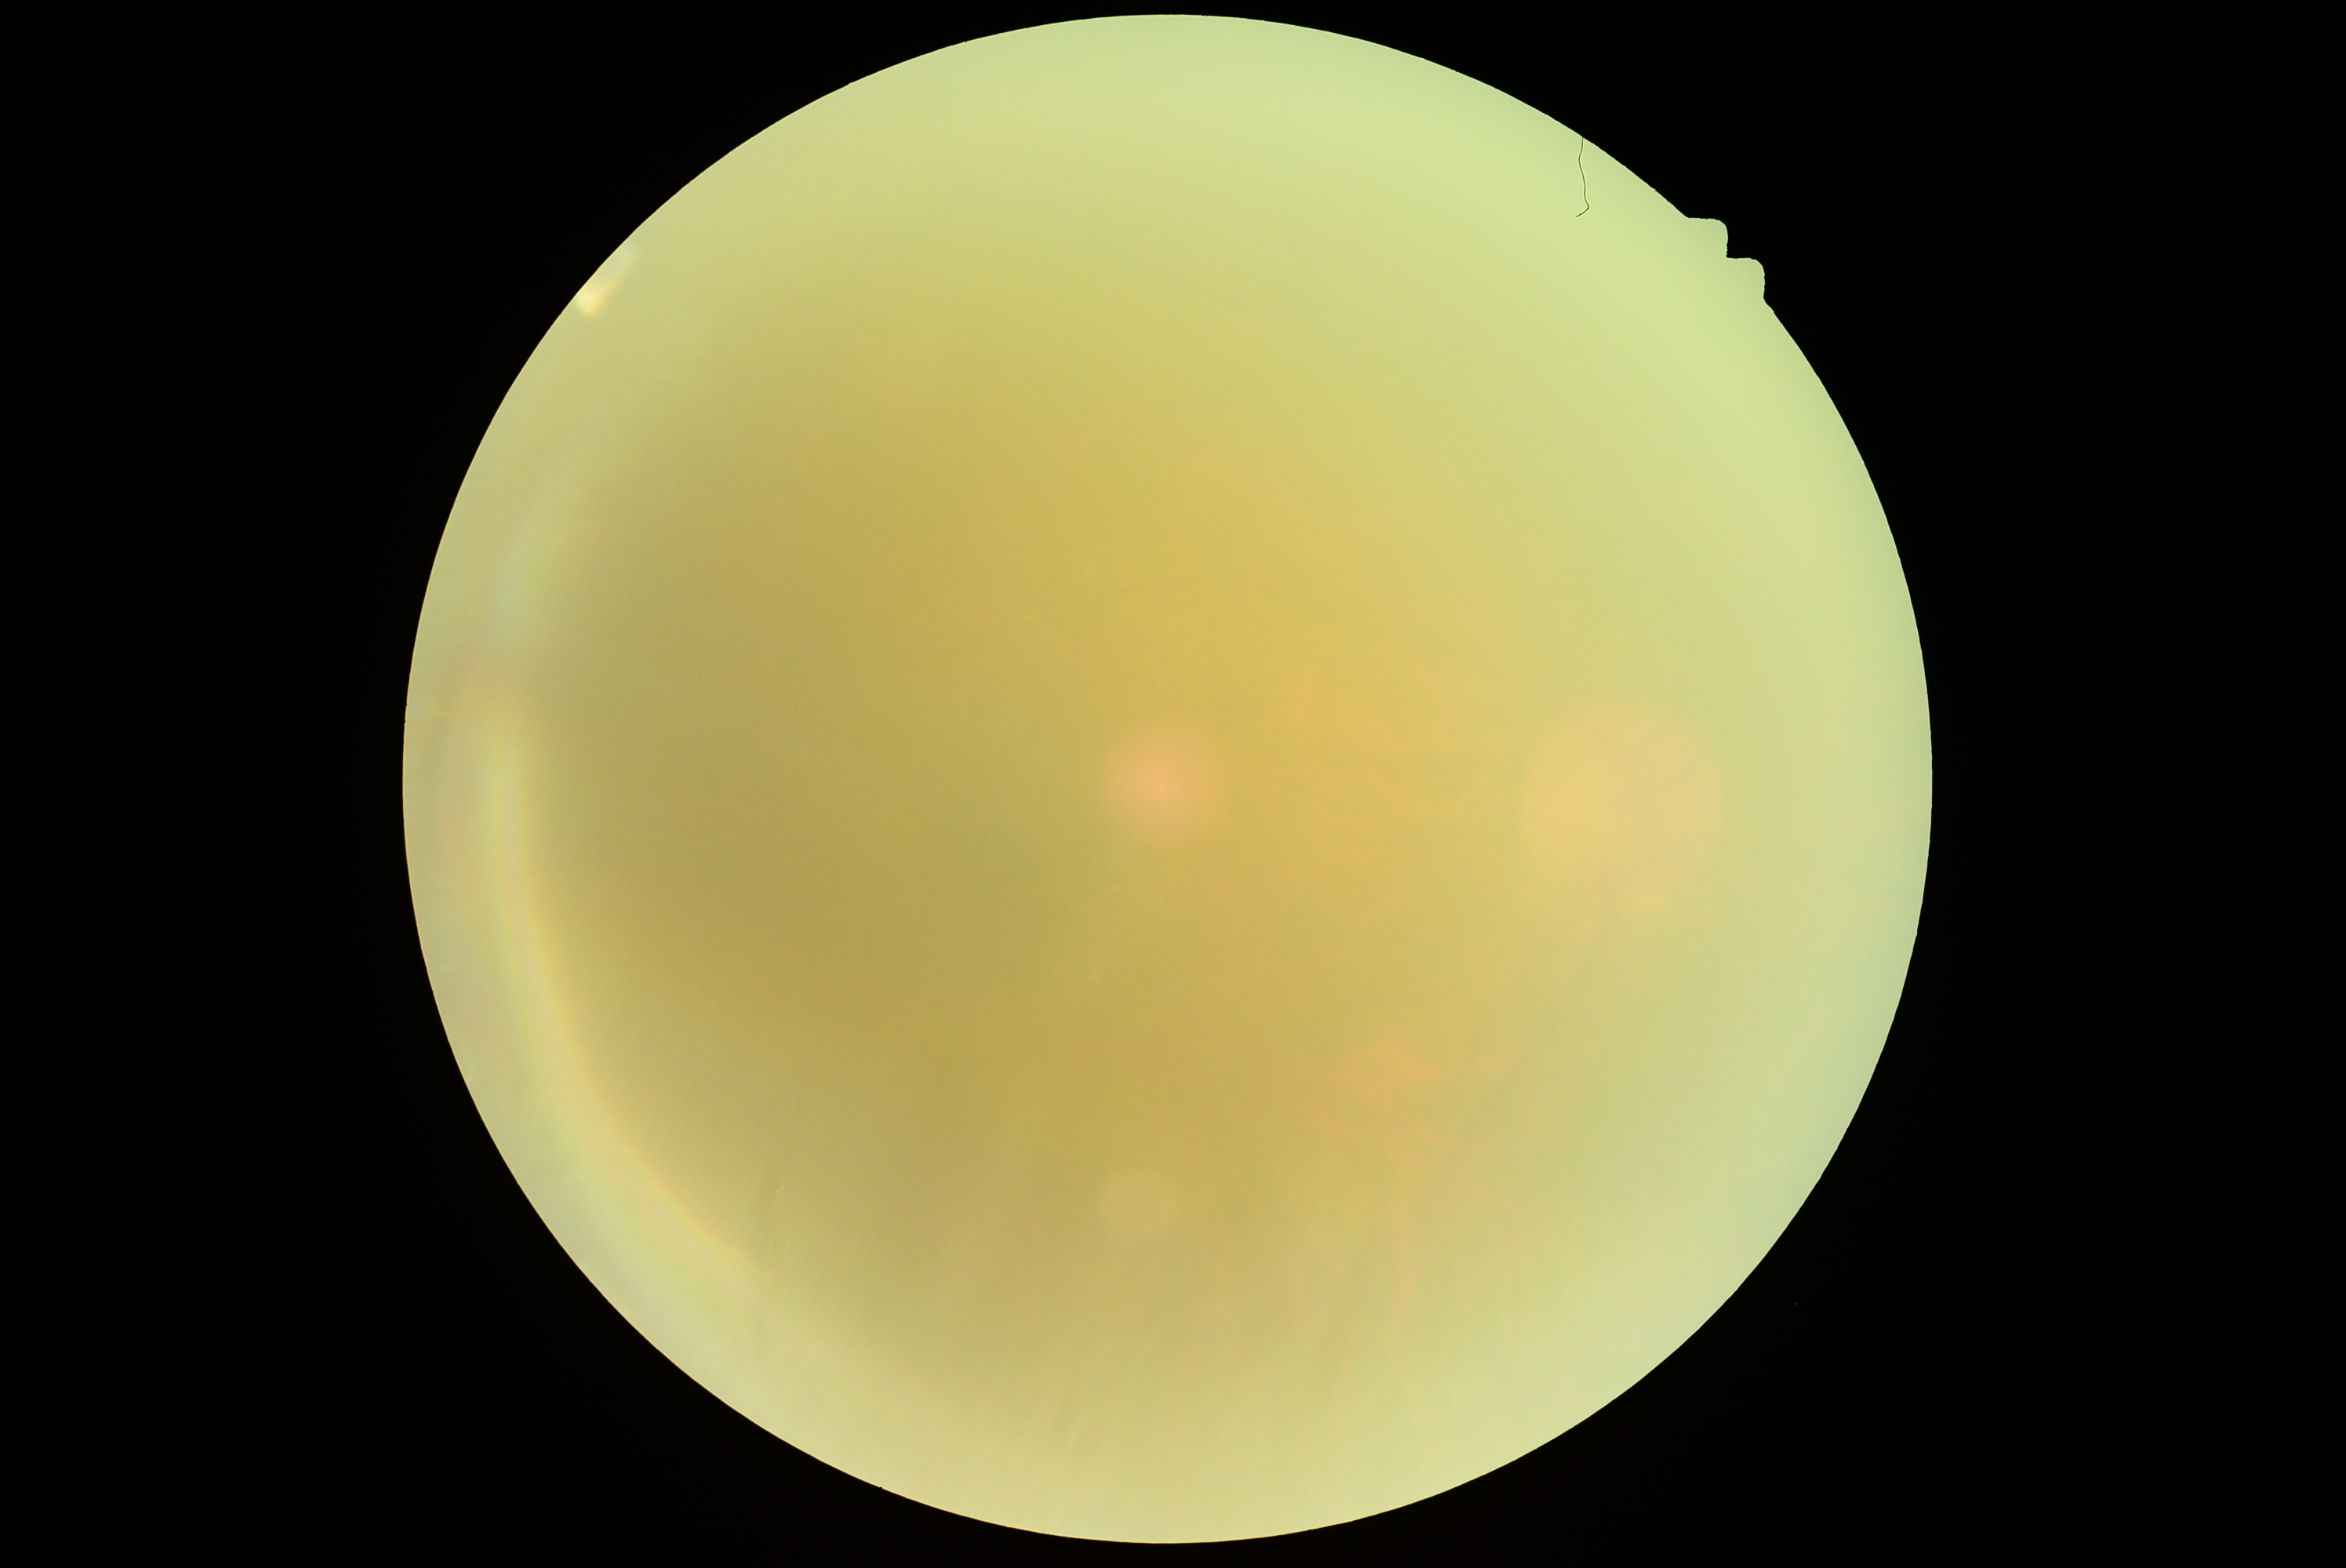
DR grade: ungradable due to poor image quality. Quality too poor to assess for DR.